Macula-centered; 2361x1568; camera: Kowa VX-10α; FOV: 50 degrees; captured after pupil dilation
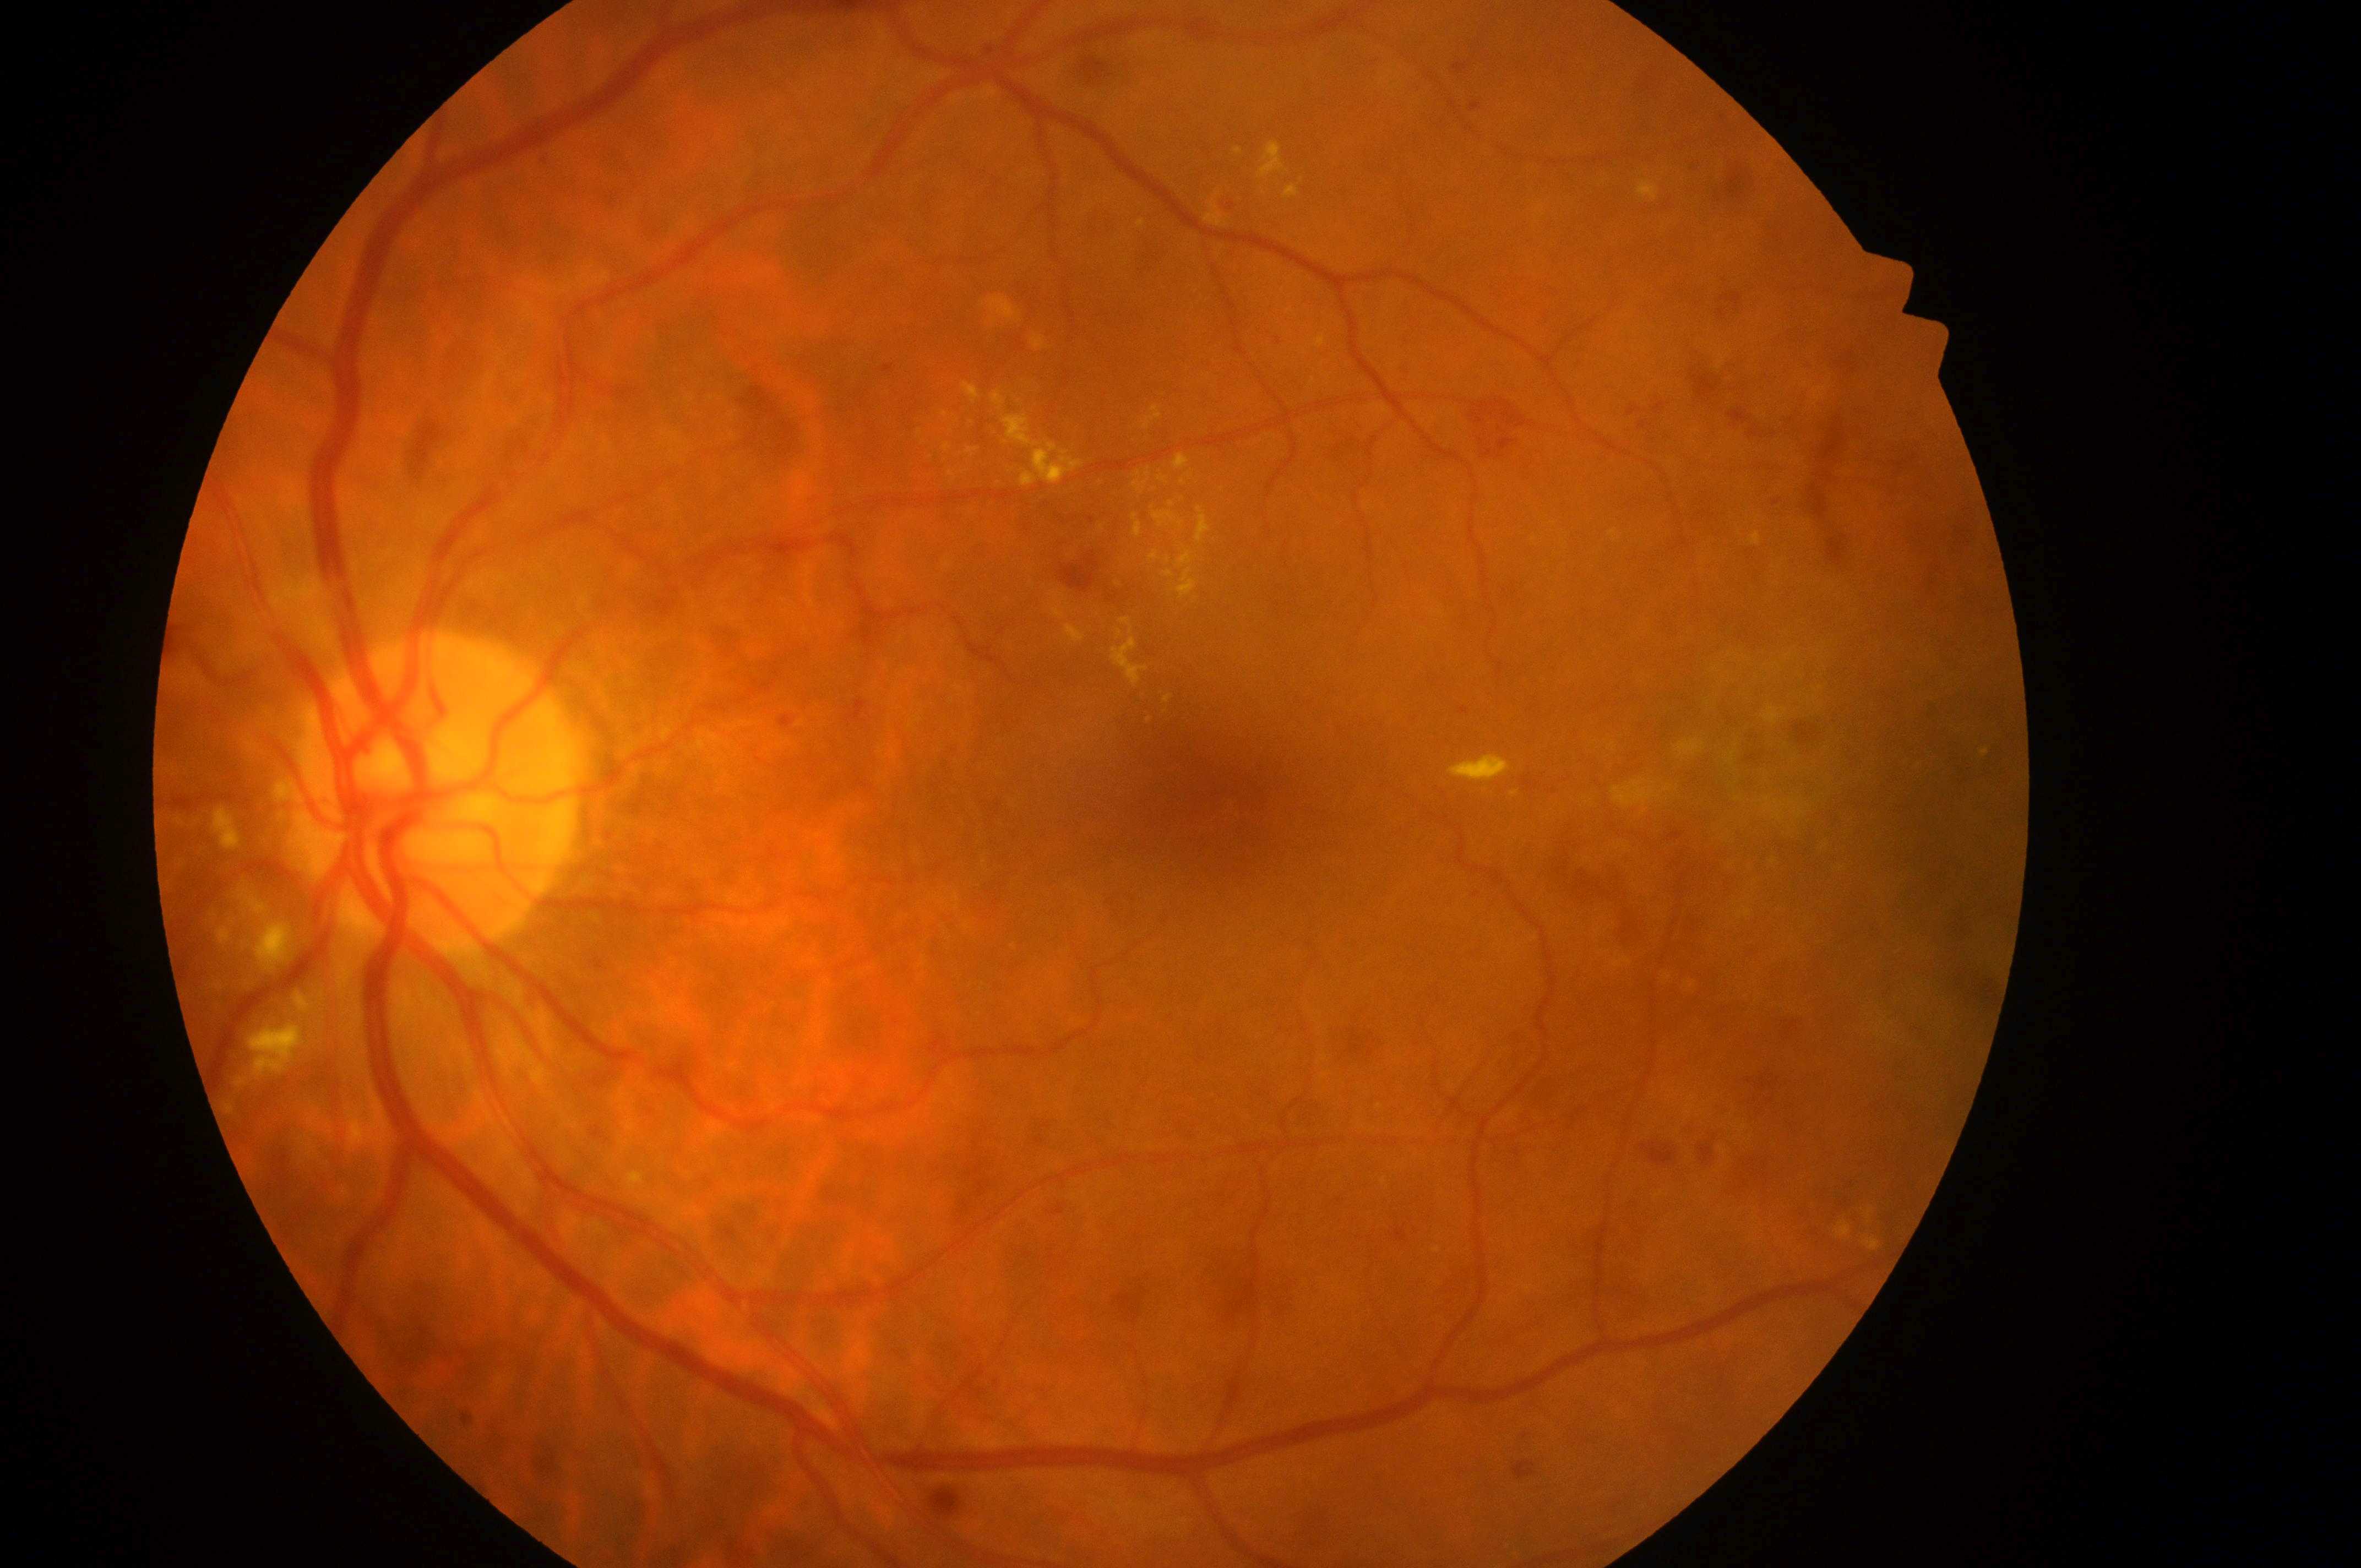 - macula center — (1213,804)
- diabetic retinopathy (DR) — severe non-proliferative diabetic retinopathy (grade 3) — more than 20 intraretinal hemorrhages in each of 4 quadrants, definite venous beading in 2 or more quadrants, or prominent intraretinal microvascular abnormalities in 1 or more quadrants, with no signs of proliferative retinopathy
- laterality — left
- diabetic macular edema (DME) — high risk (grade 2) — hard exudates within one disc diameter of the macula center
- disc center — (429,804)